Nonmydriatic. Modified Davis classification
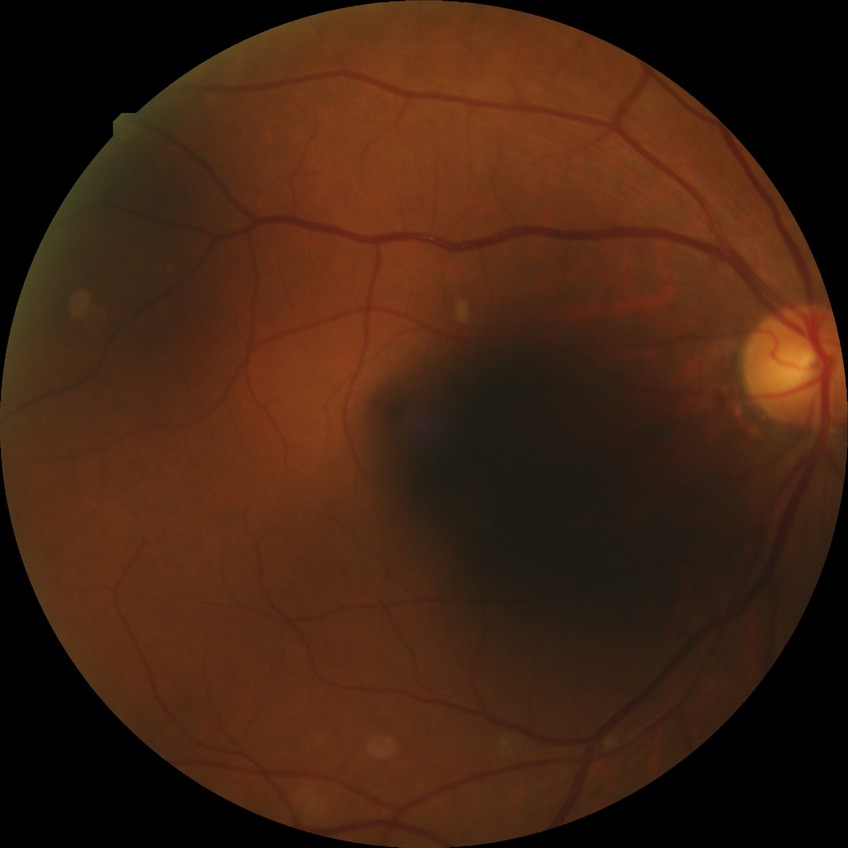

Diabetic retinopathy (DR) is PPDR (pre-proliferative diabetic retinopathy).
Disease class: non-proliferative diabetic retinopathy.